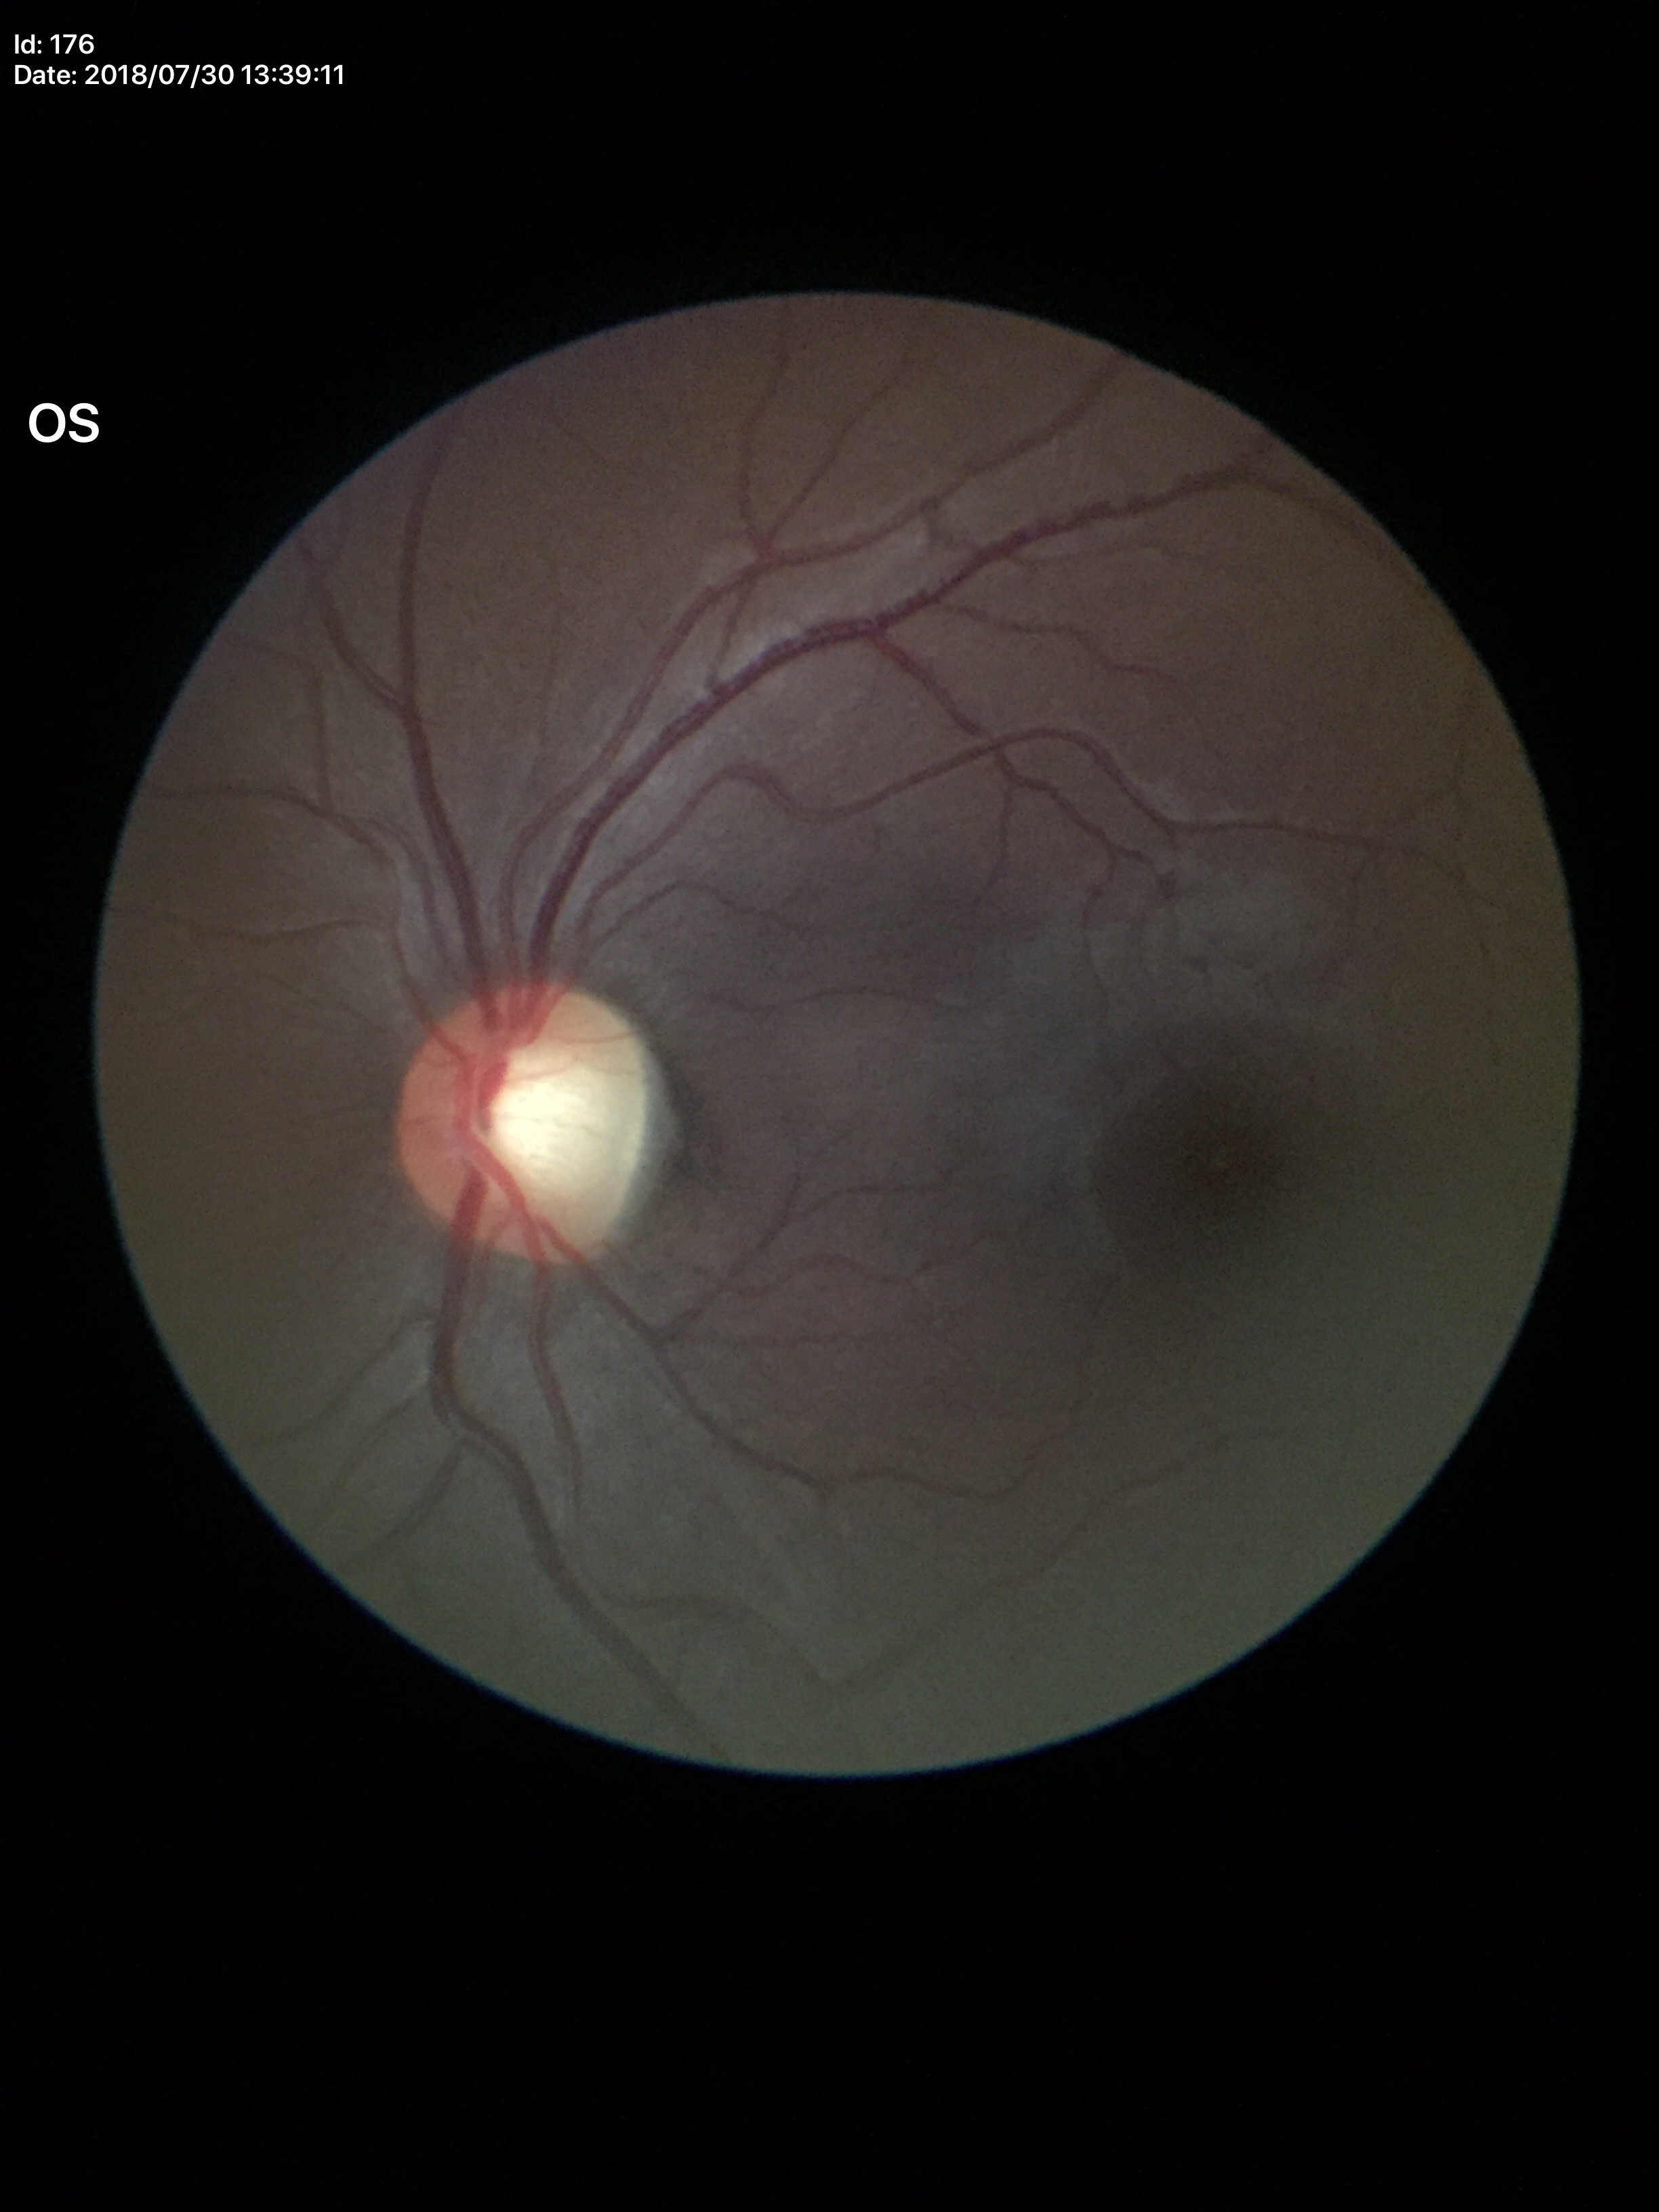
Findings:
* Glaucoma screening · suspicious (three of five ophthalmologists flagged glaucoma suspect)
* vertical C/D ratio (VCDR) · 0.59